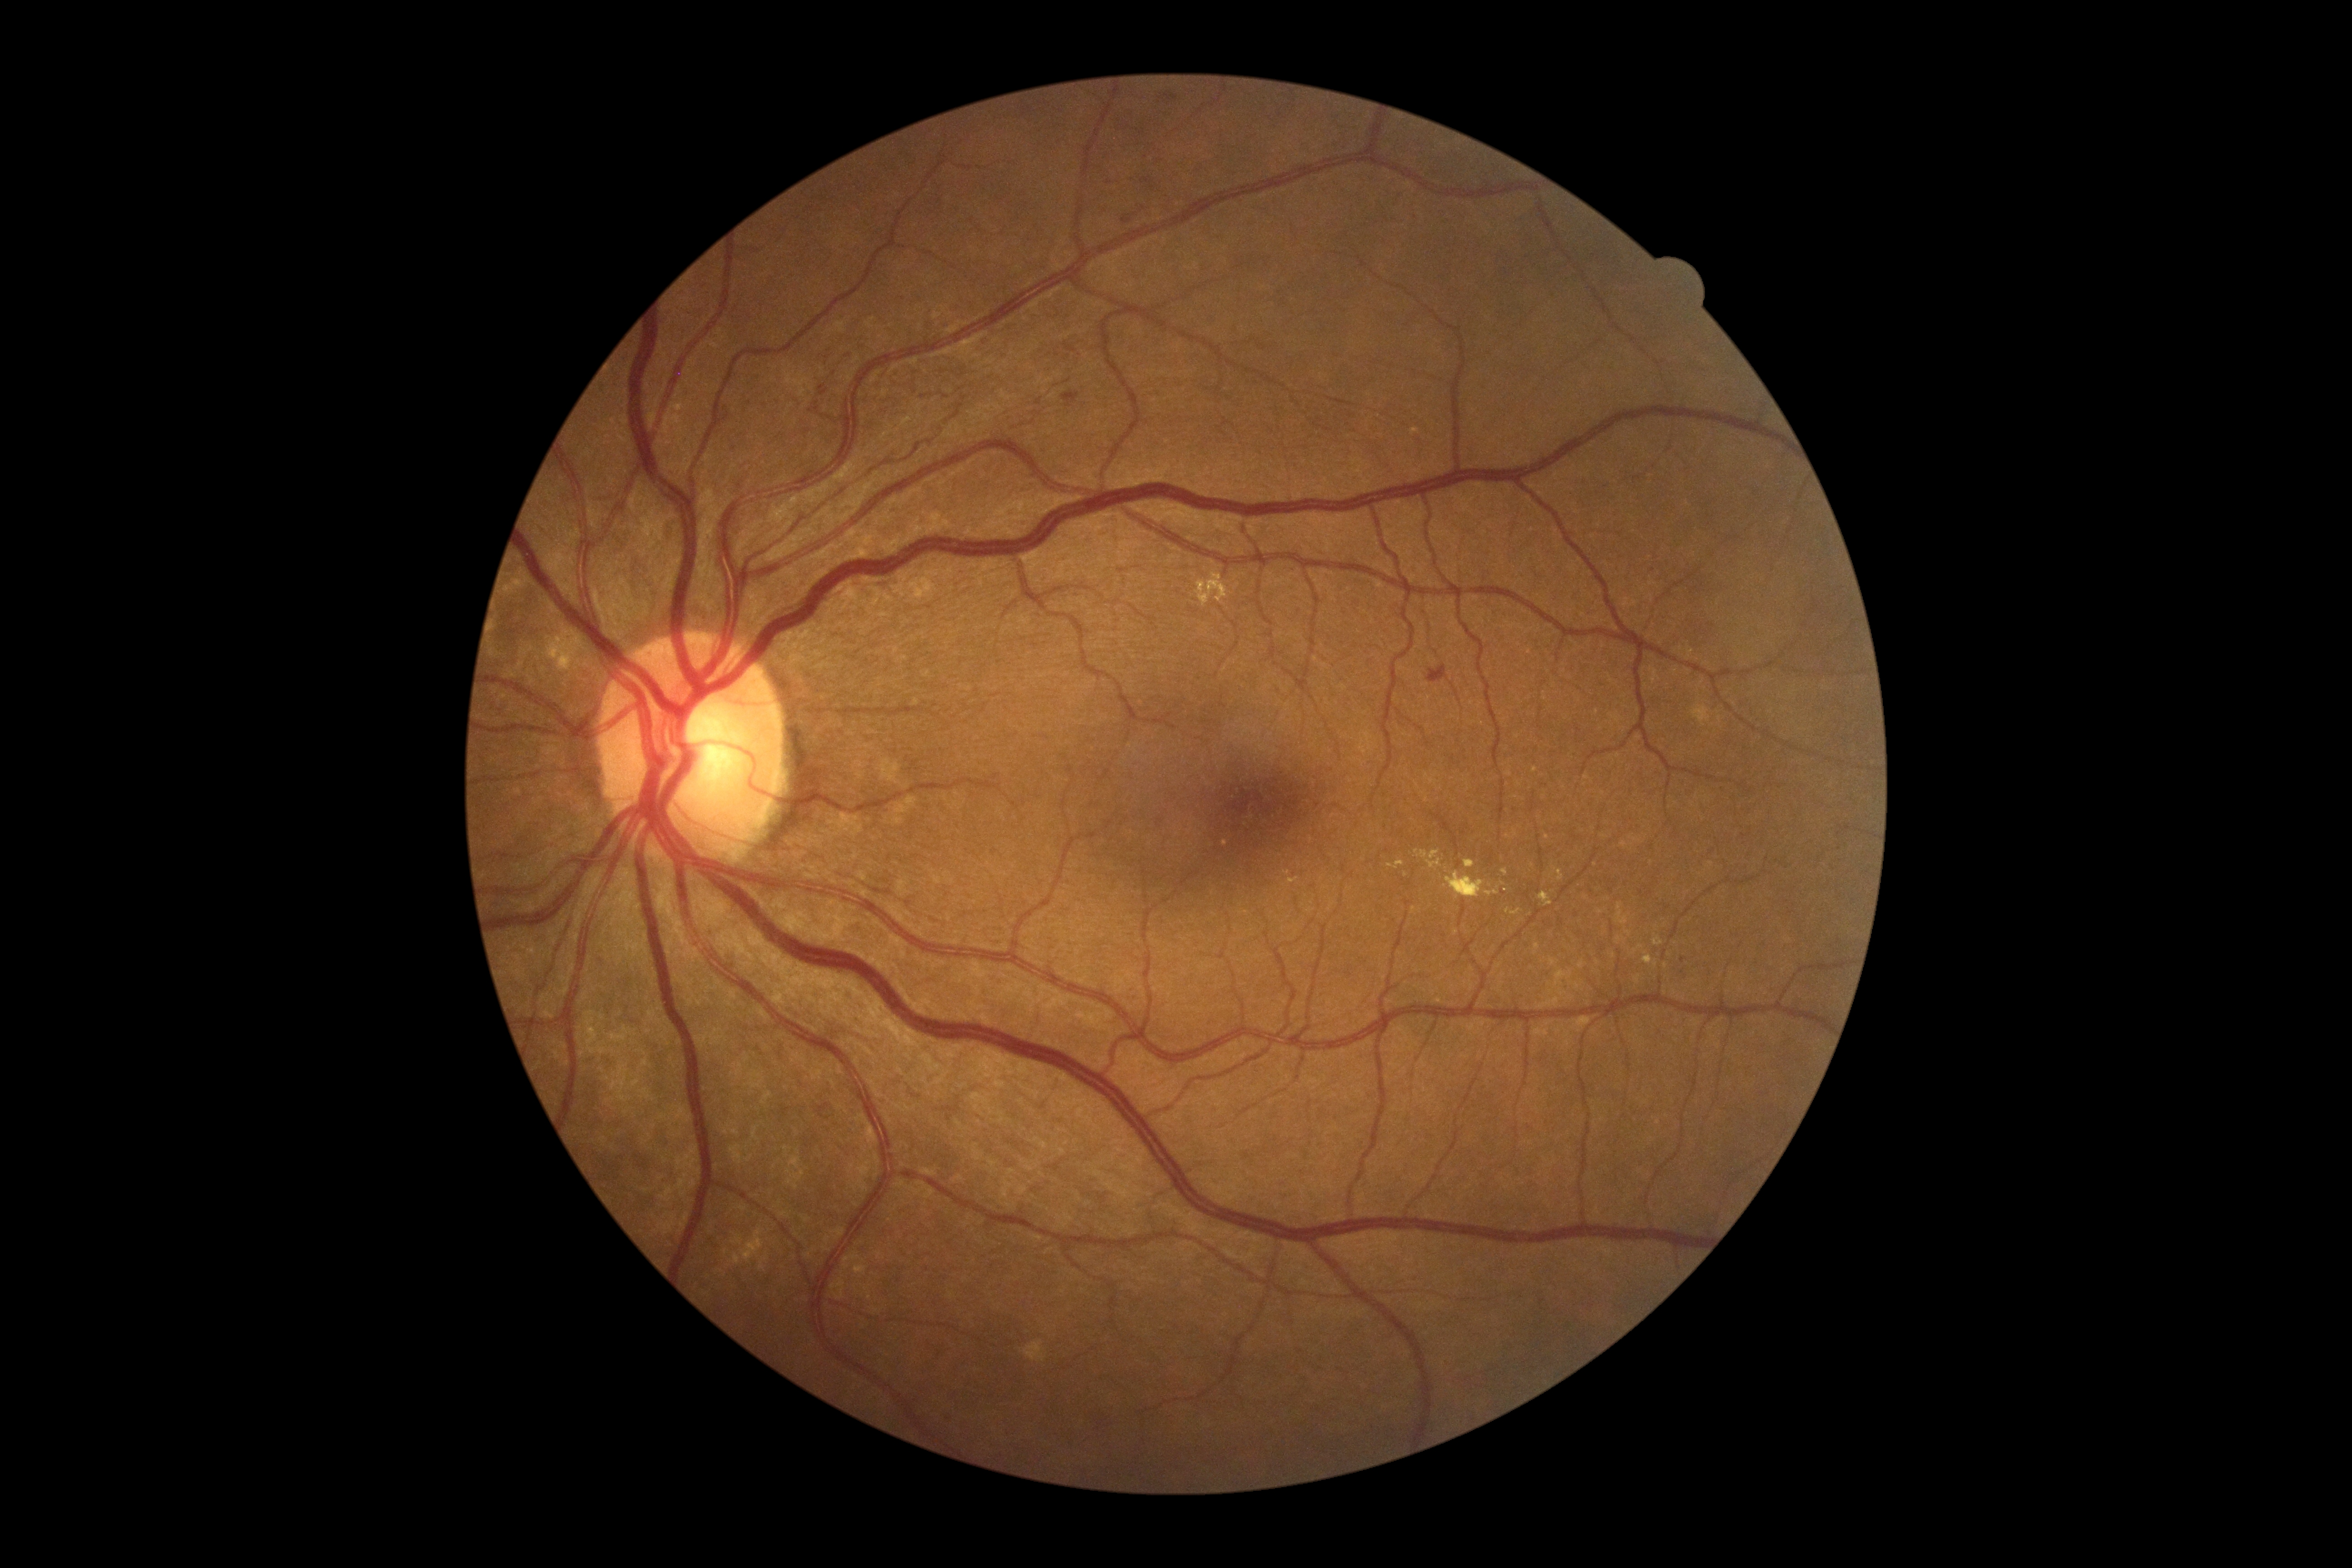

DR severity is 2 — more than just microaneurysms but less than severe NPDR
Representative lesions:
EXs (continued) = x1=544 y1=624 x2=572 y2=660 | x1=1539 y1=892 x2=1552 y2=907 | x1=1445 y1=871 x2=1499 y2=899 | x1=1388 y1=860 x2=1405 y2=870 | x1=1463 y1=860 x2=1474 y2=868
Smaller EXs around Point(1515, 833) | Point(1547, 838) | Point(1531, 914) | Point(1508, 911) | Point(1505, 873) | Point(1532, 865)